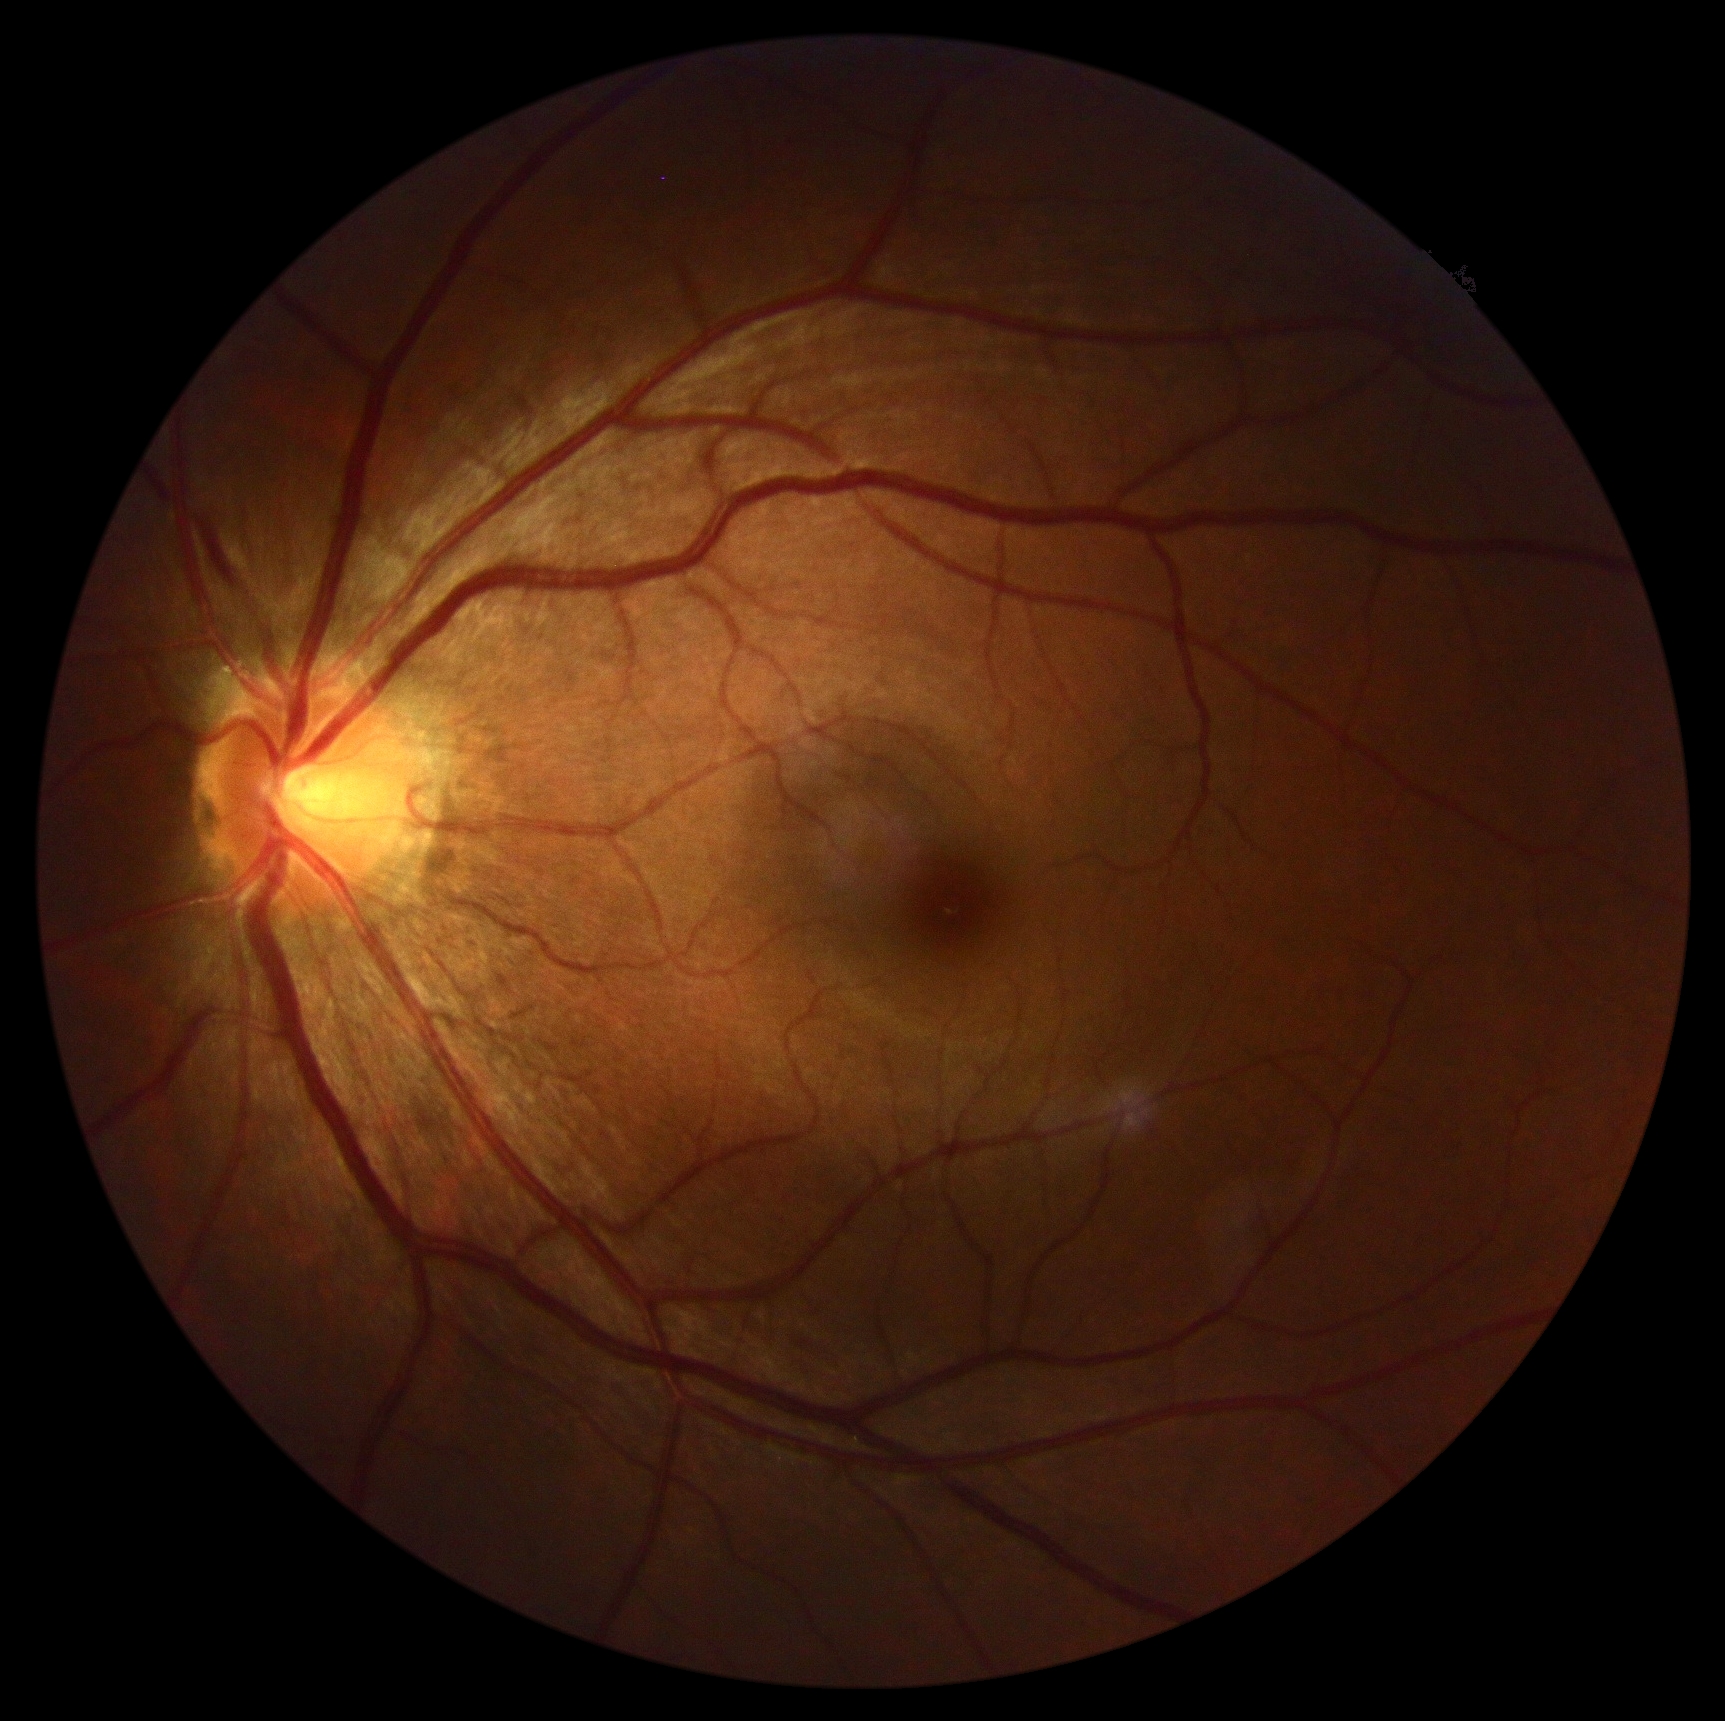

  dr_grade: no apparent diabetic retinopathy (grade 0)